Graded on the modified Davis scale. Acquired with a NIDEK AFC-230. FOV: 45 degrees. 848 by 848 pixels. Fundus photo. No pharmacologic dilation: 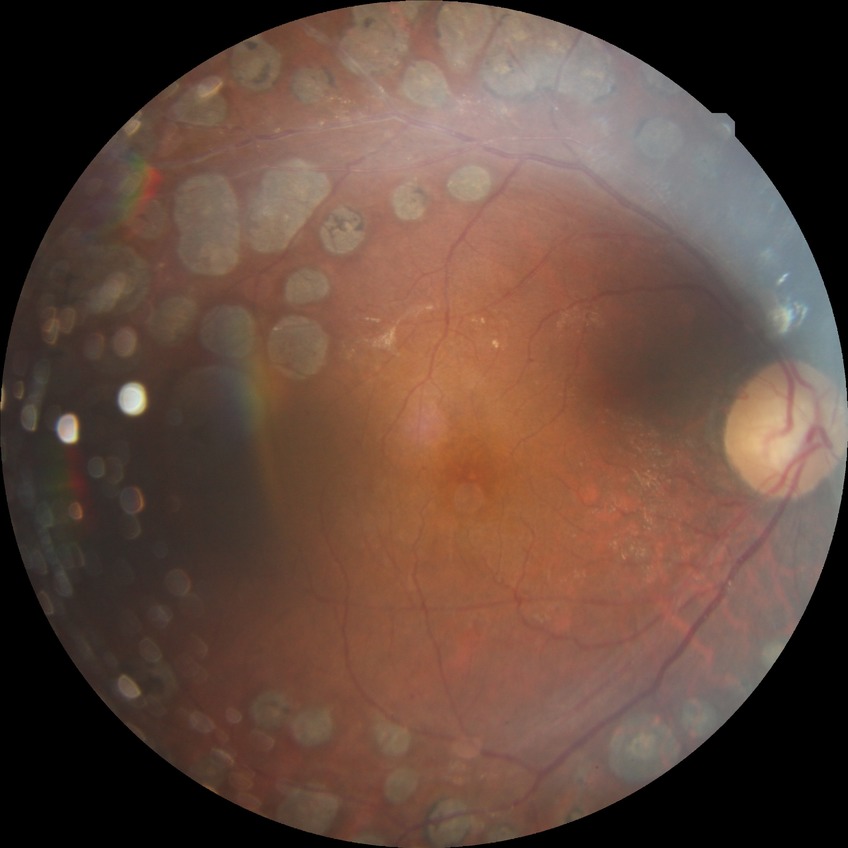
Modified Davis grade is PDR.